Infant wide-field fundus photograph. 1240 x 1240 pixels:
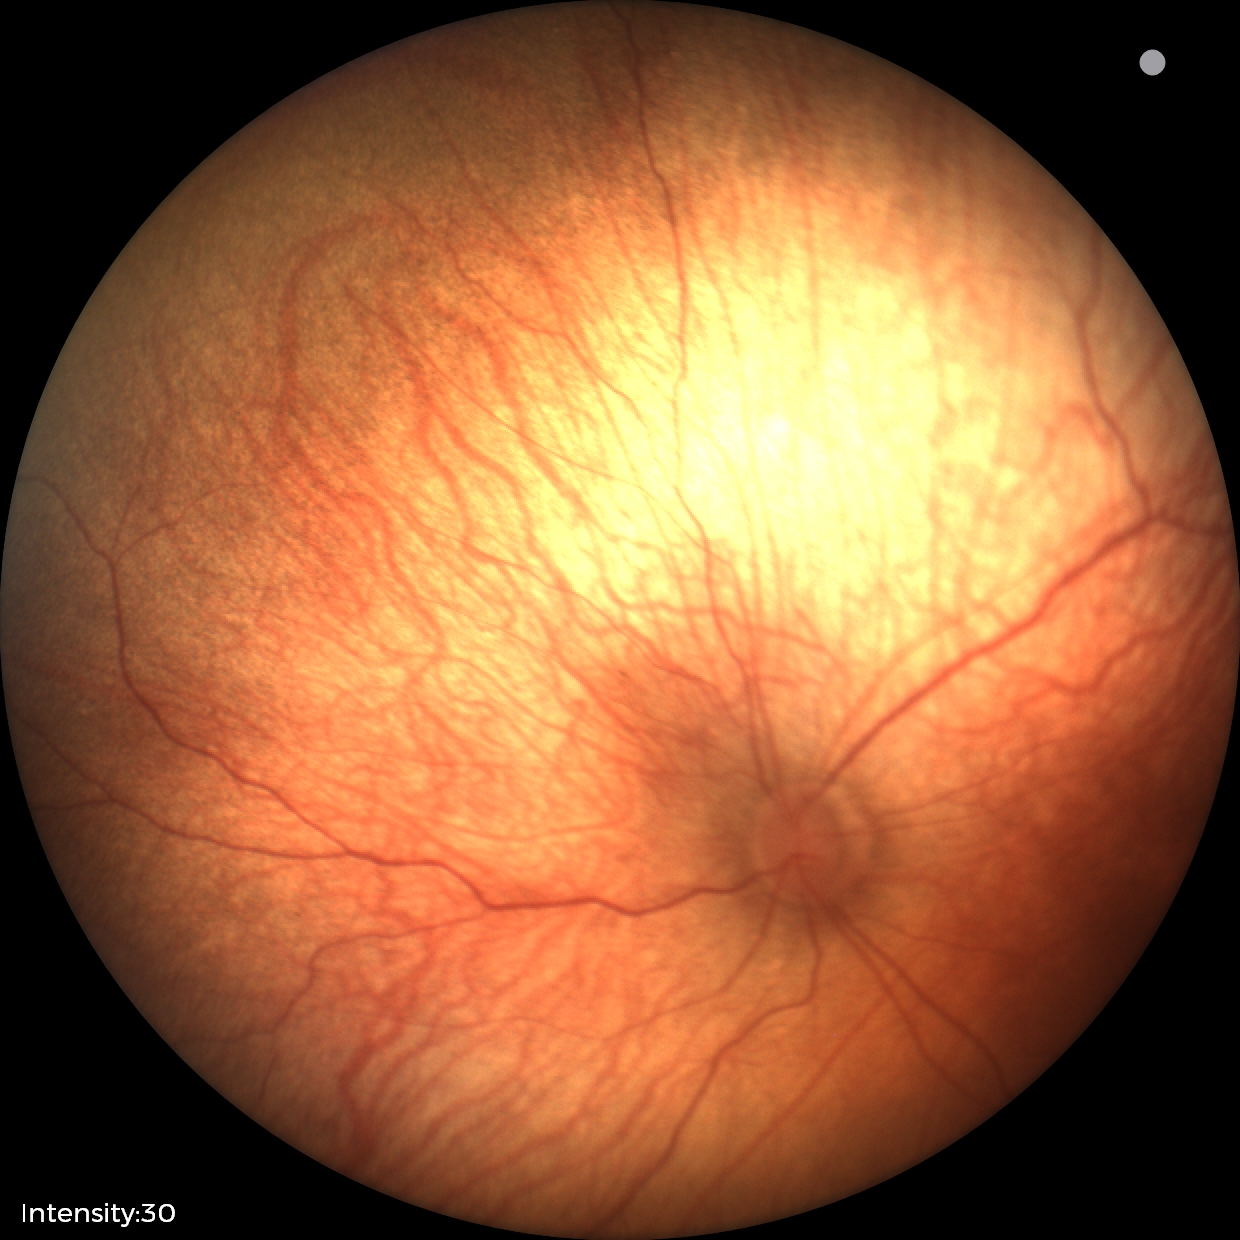

Impression: normal fundus examination.